45-degree field of view
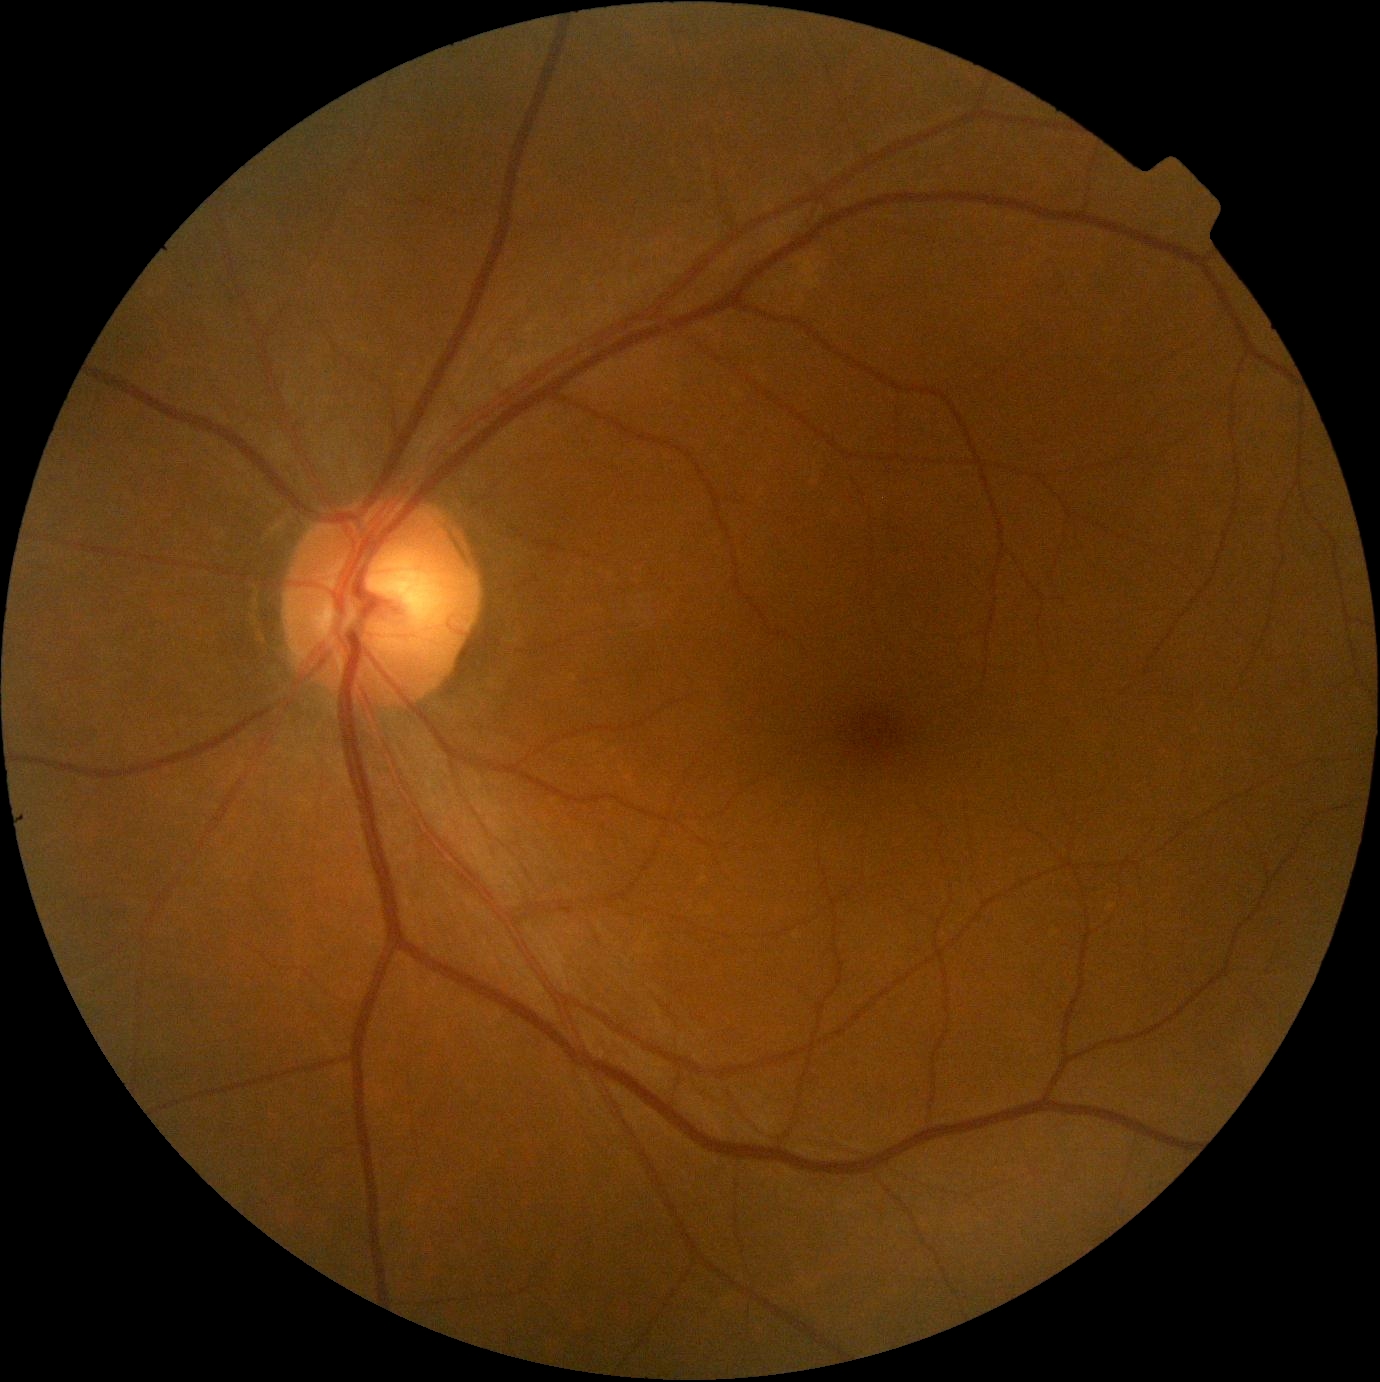 DR impression@no DR findings; DR severity@grade 0 (no apparent retinopathy).